Field includes the optic disc and macula
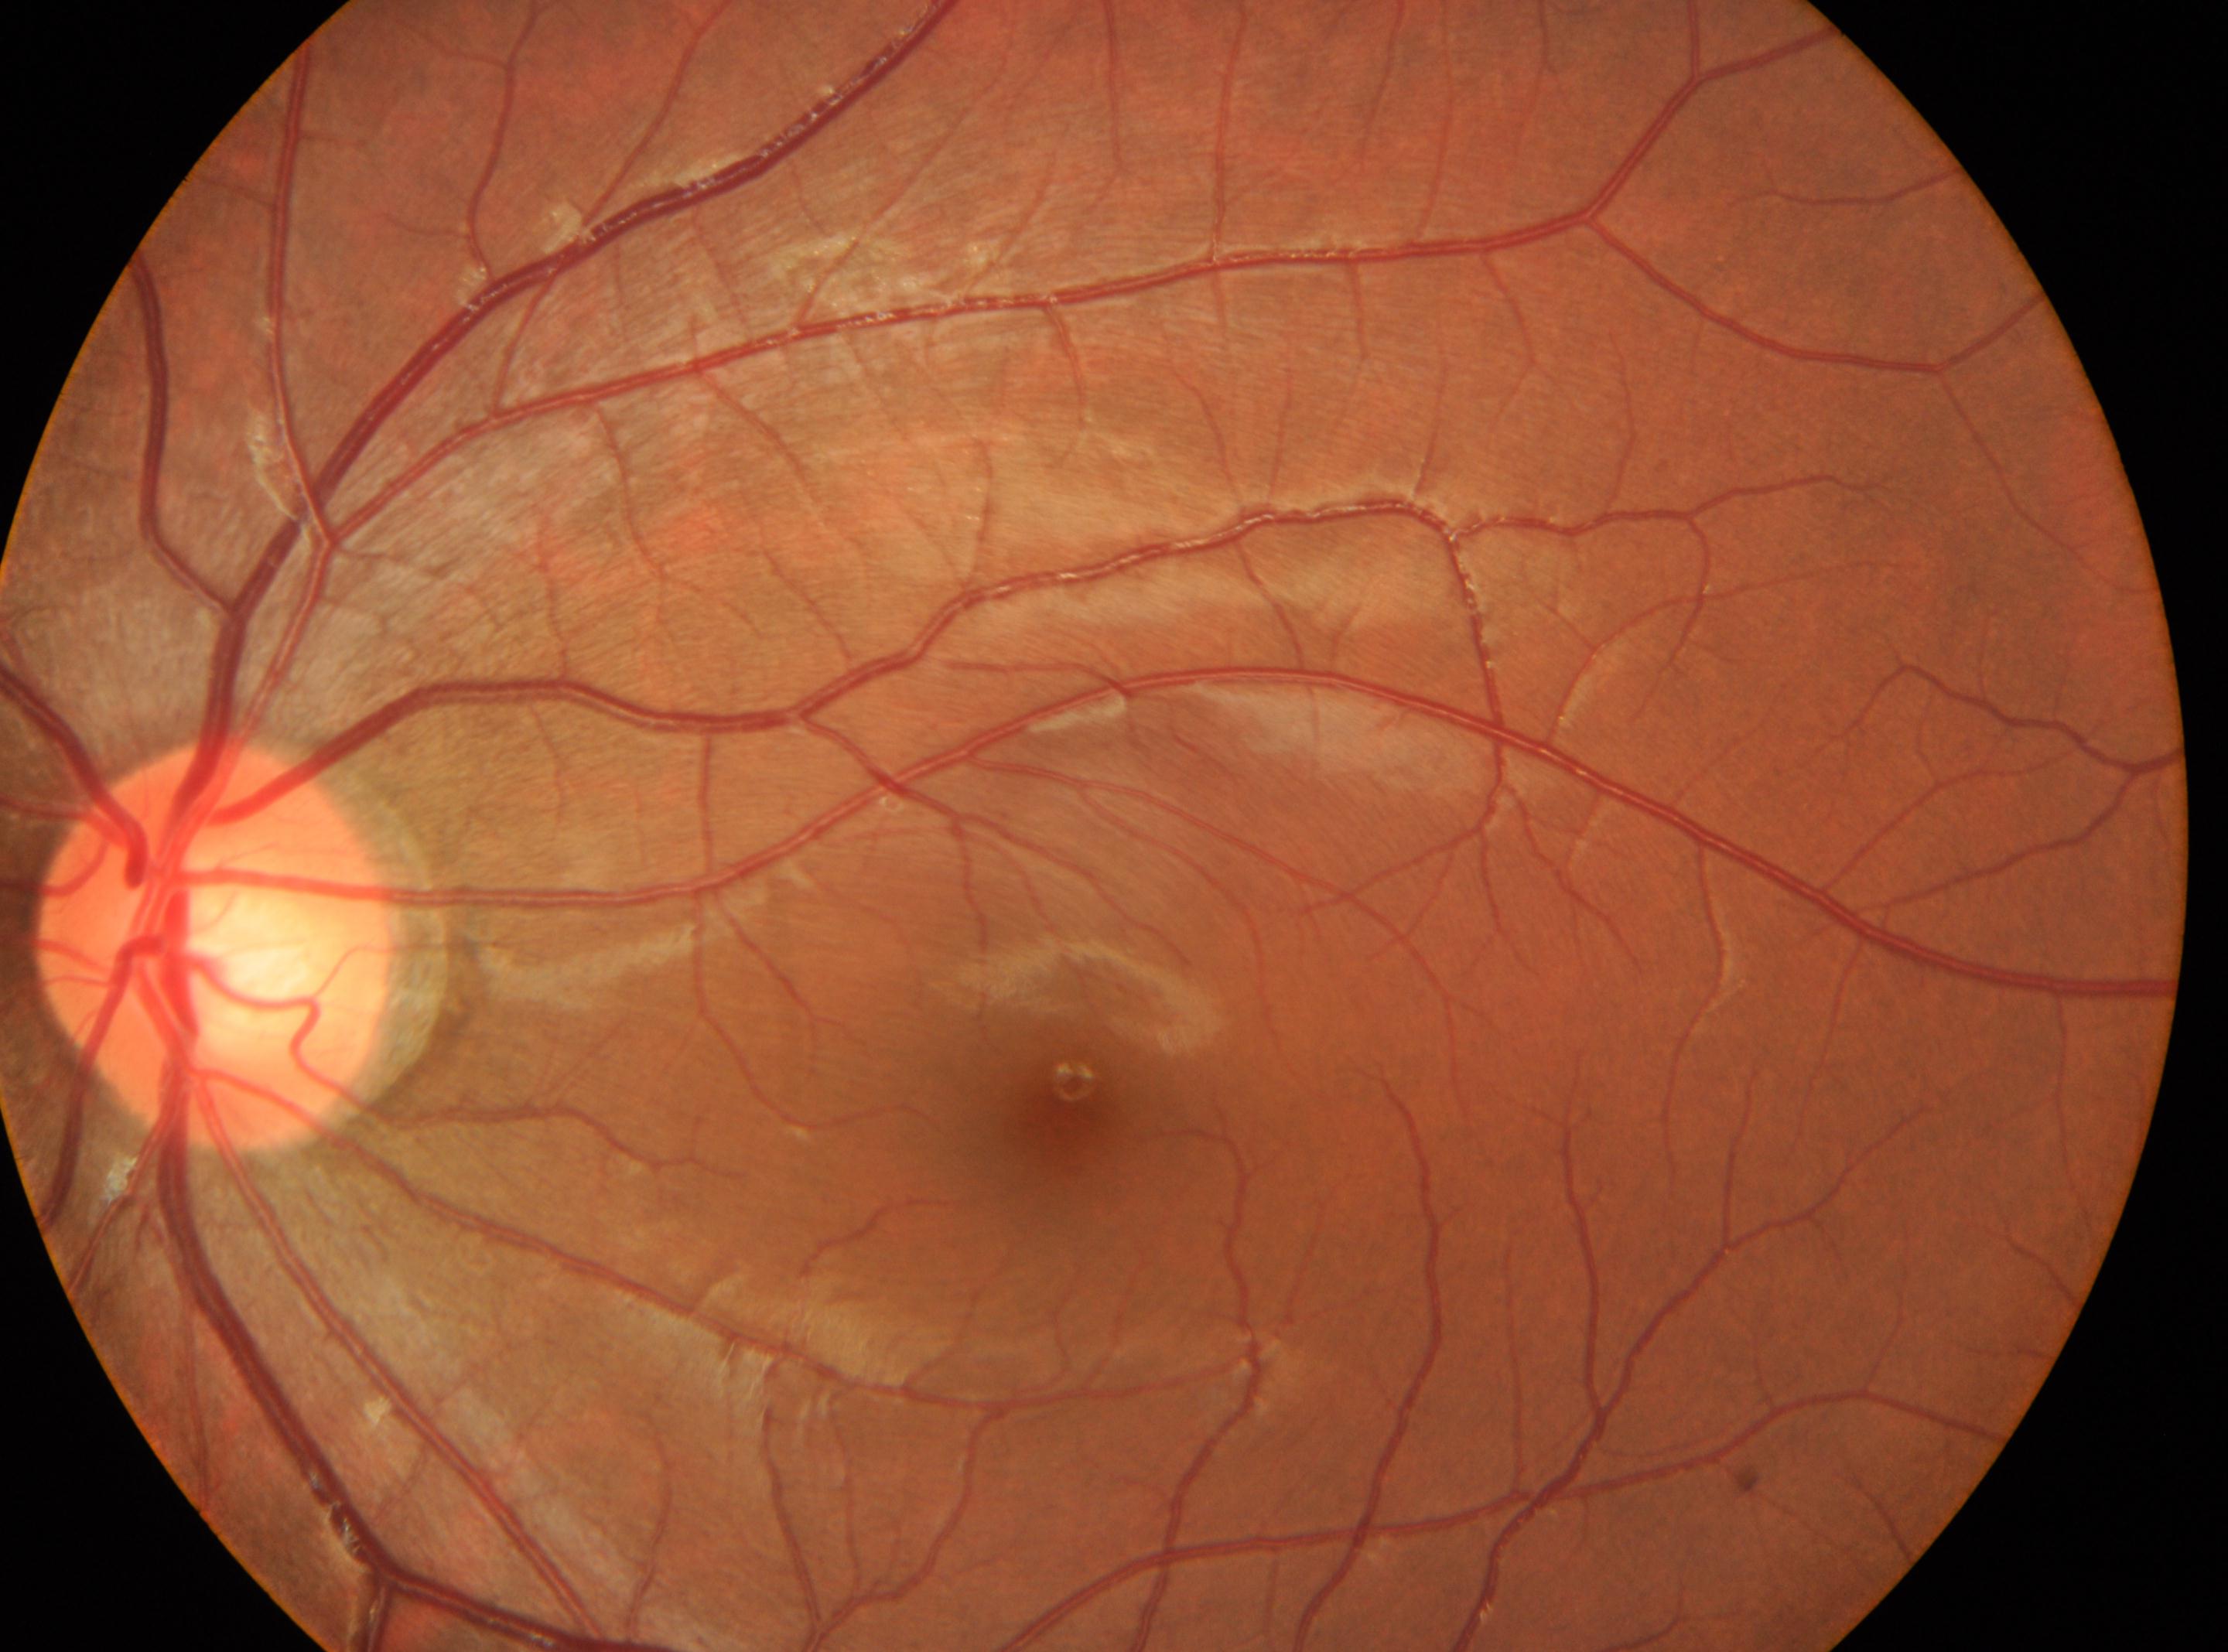 oculus sinister
optic disc: (217, 944)
diabetic retinopathy: grade 0
fovea center: (1055, 1120)
No signs of diabetic retinopathy